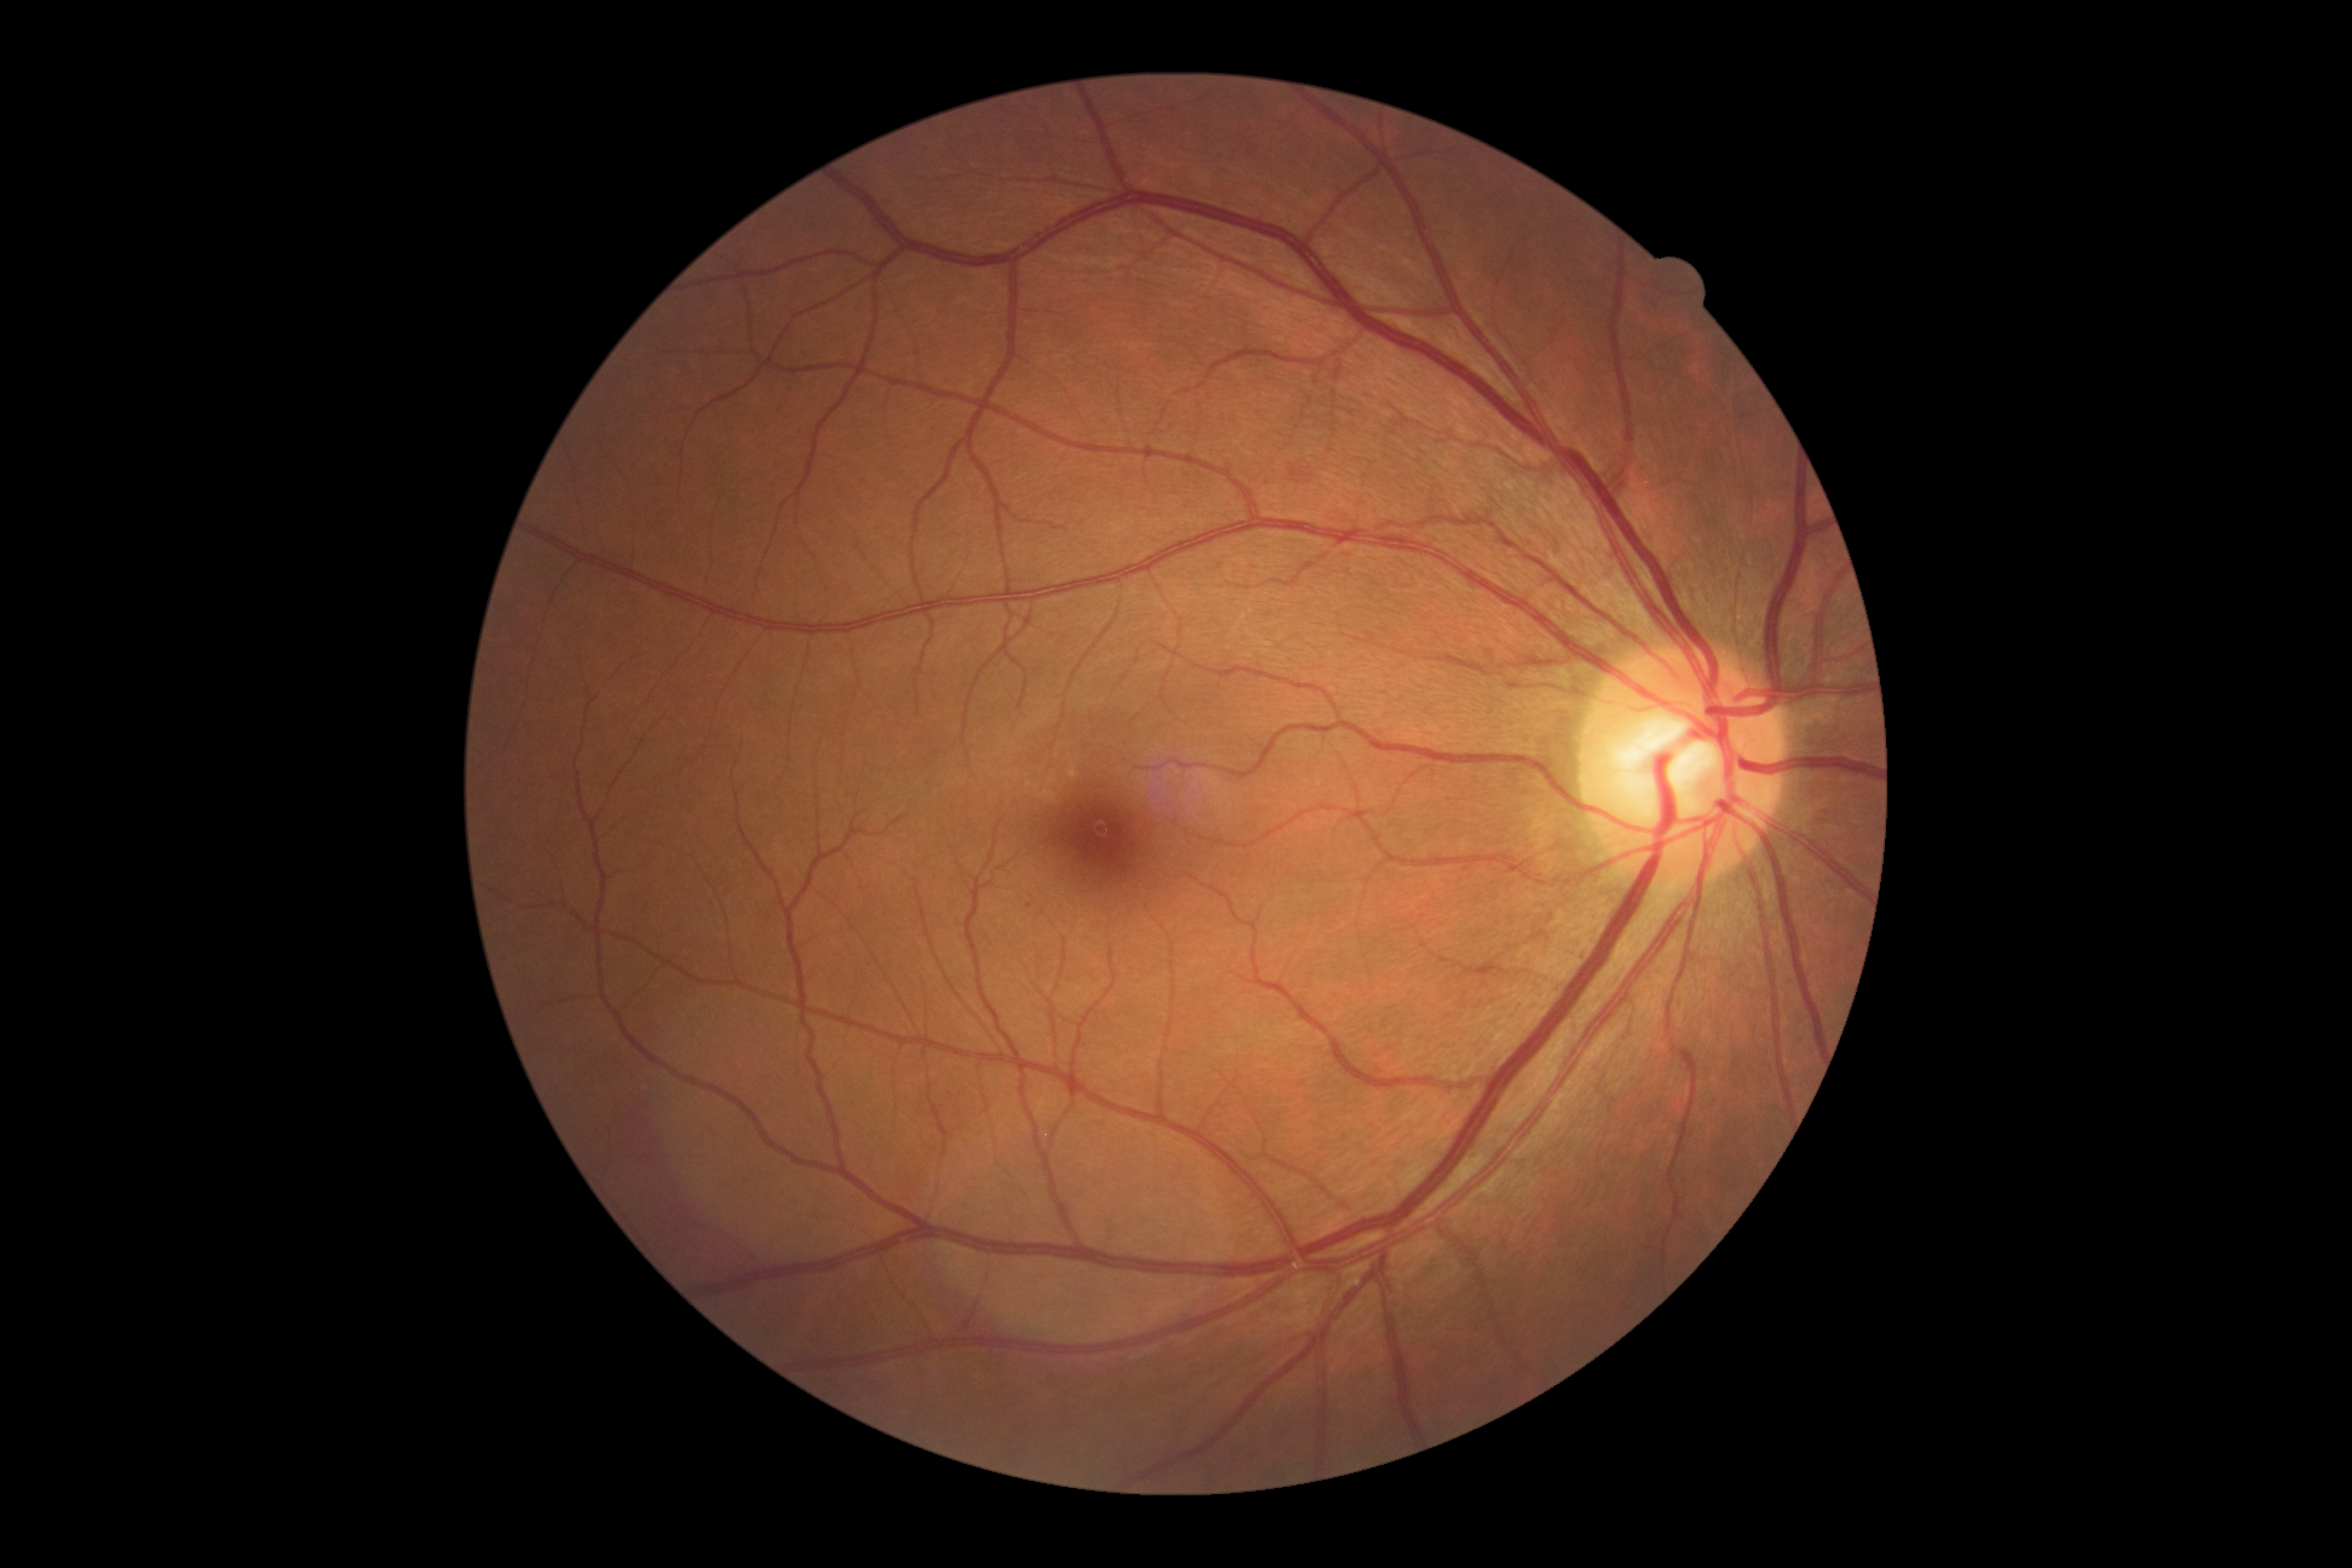

{
  "dr_grade": "grade 2 (moderate NPDR)"
}